45° field of view, NIDEK AFC-230, without pupil dilation, 848 by 848 pixels — 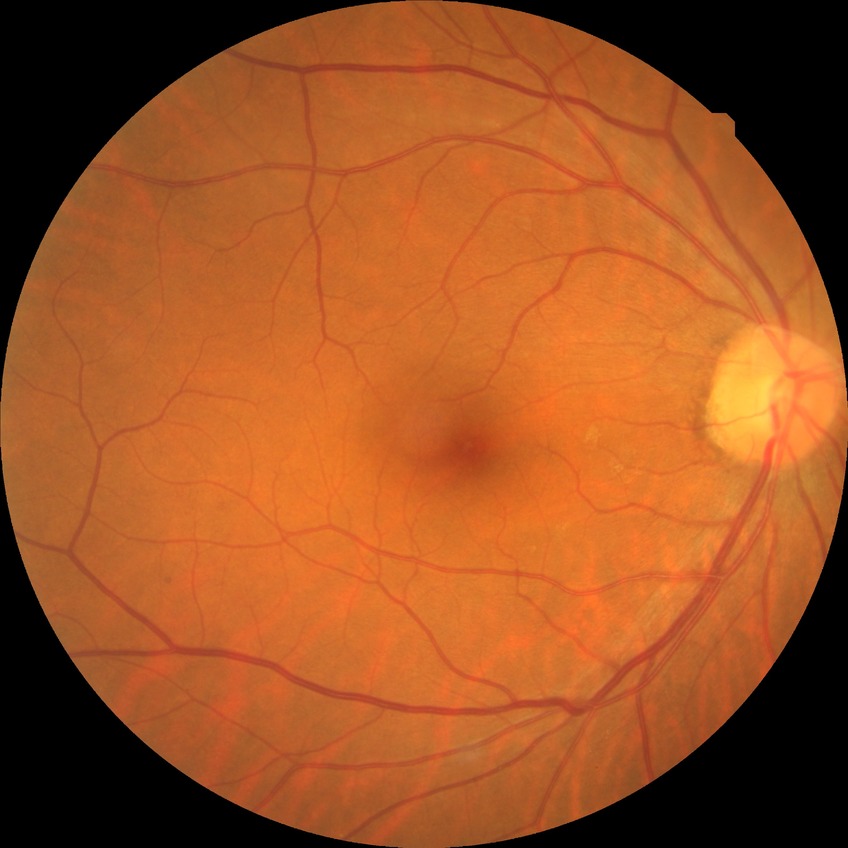 Diabetic retinopathy (DR) is no diabetic retinopathy (NDR).